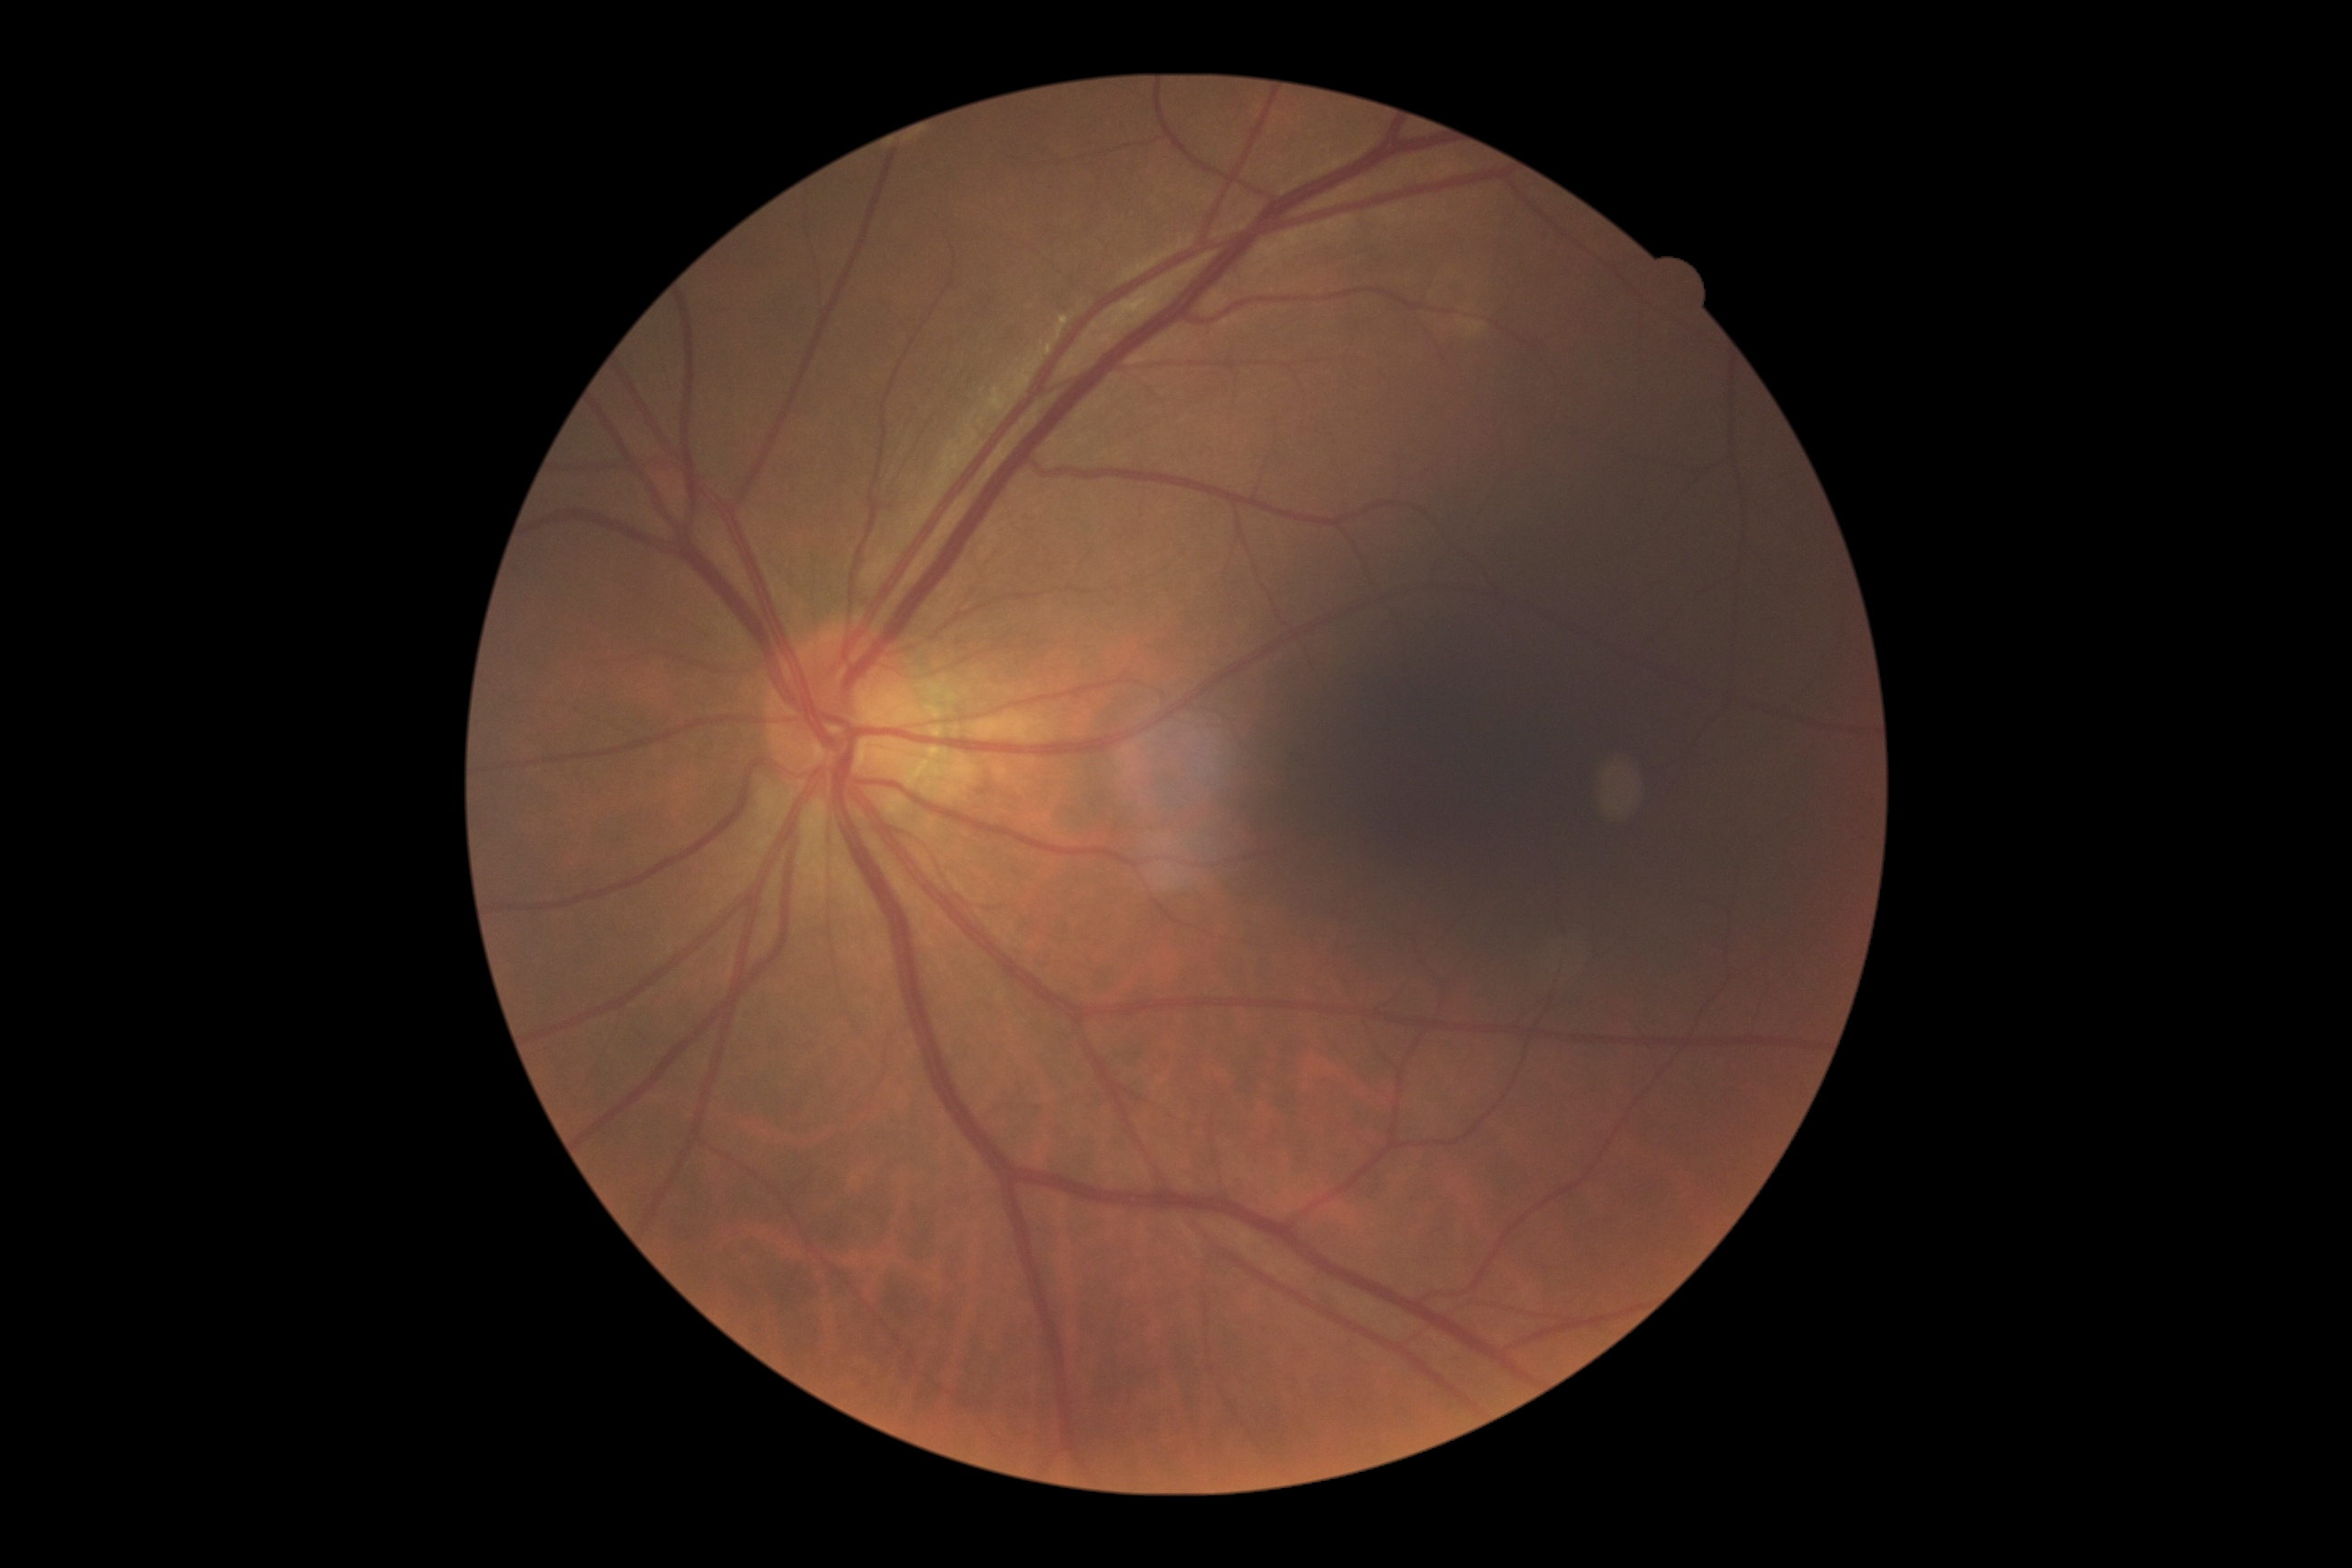 Diabetic retinopathy (DR) is no apparent retinopathy (grade 0) — no visible signs of diabetic retinopathy. No apparent diabetic retinopathy.